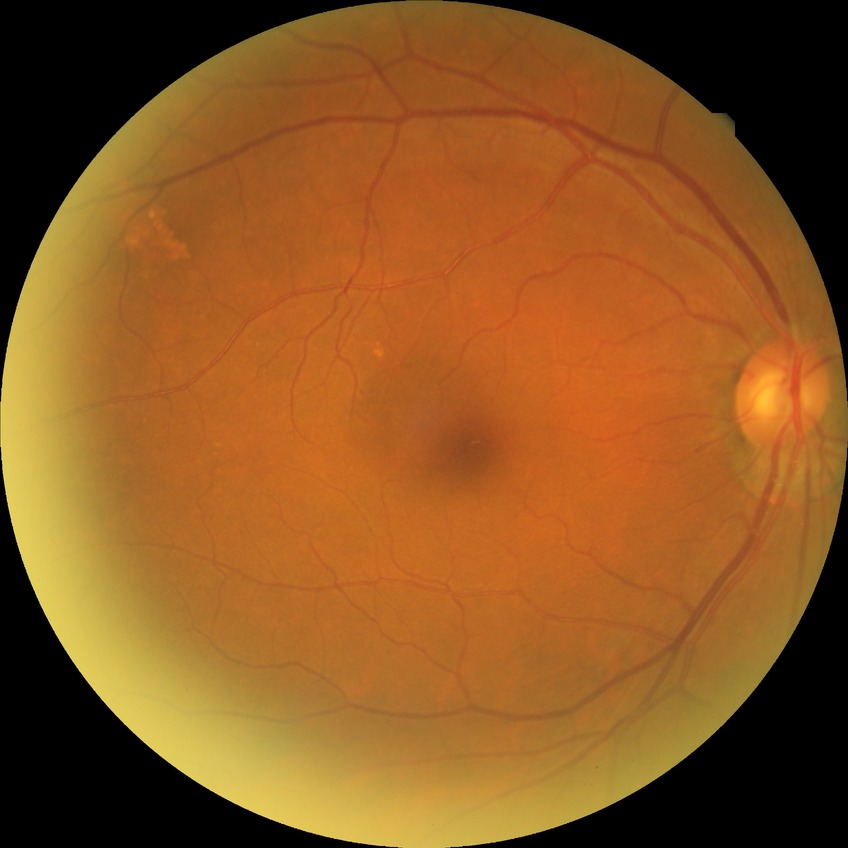
Diabetic retinopathy stage: no diabetic retinopathy.